Camera: Phoenix ICON (100° FOV) · infant wide-field fundus photograph:
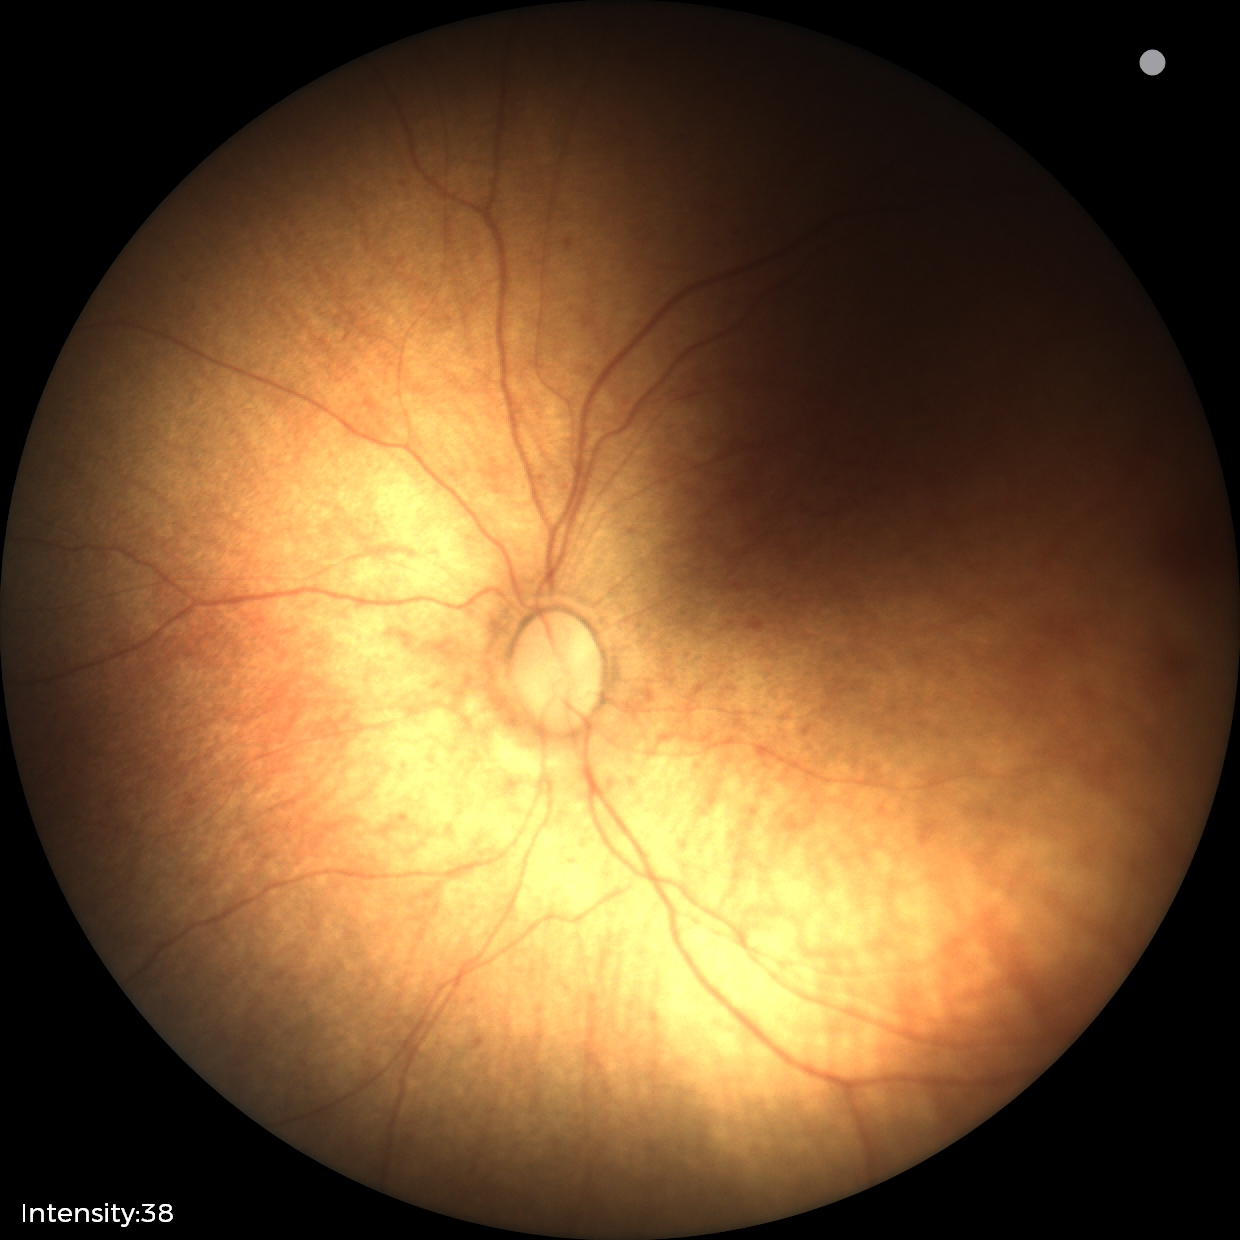 Examination with physiological retinal findings.